Acquired with a NIDEK AFC-230. Without pupil dilation. Color fundus photograph
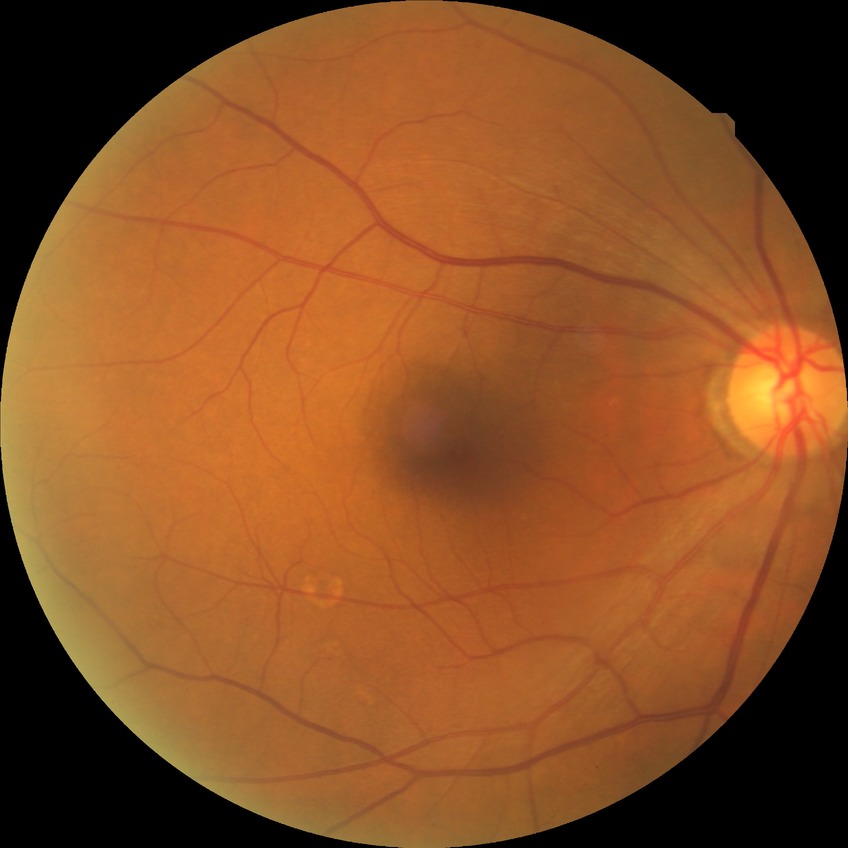

diabetic retinopathy grade = no diabetic retinopathy.